NIDEK AFC-230.
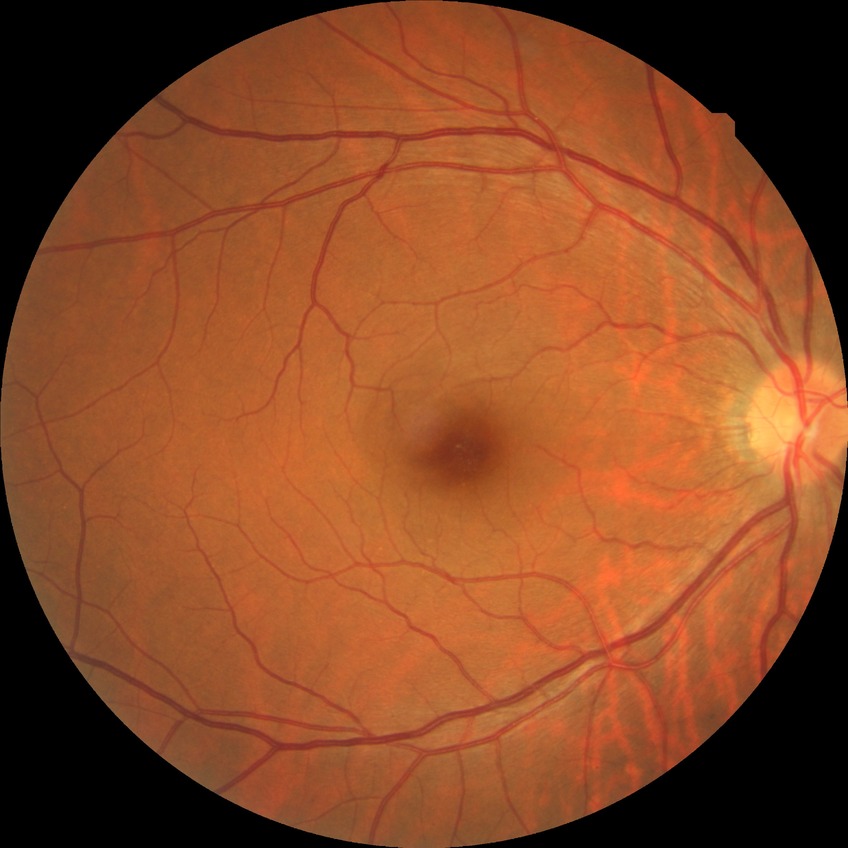 Diabetic retinopathy grade: no diabetic retinopathy.